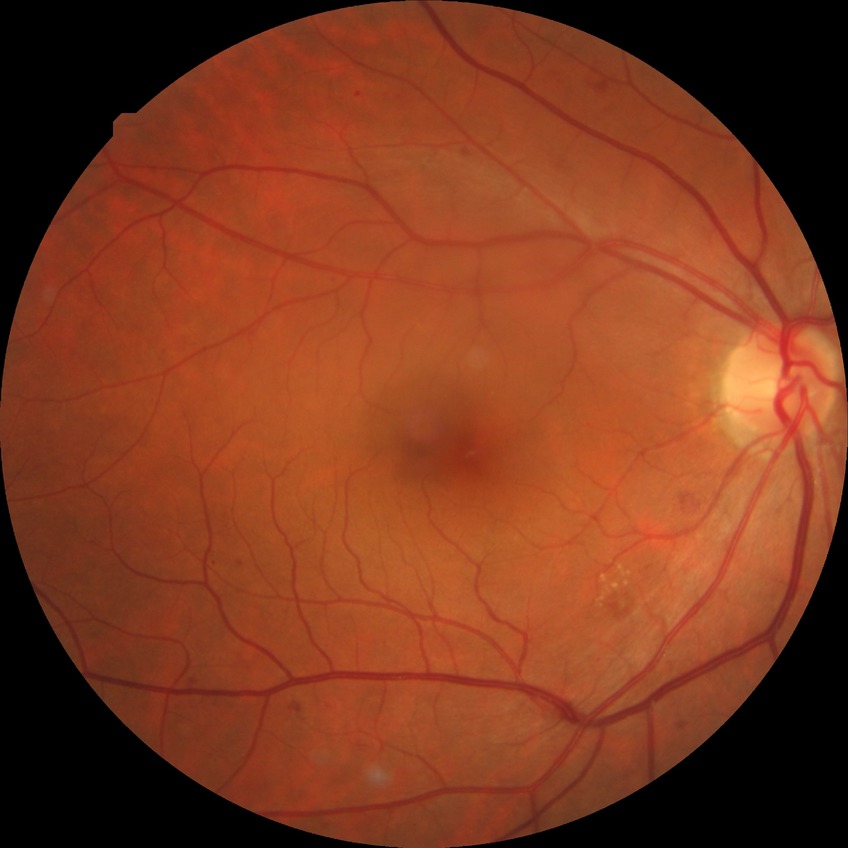

DR class = non-proliferative diabetic retinopathy; DR grade = SDR.